Diabetic retinopathy graded by the modified Davis classification · nonmydriatic: 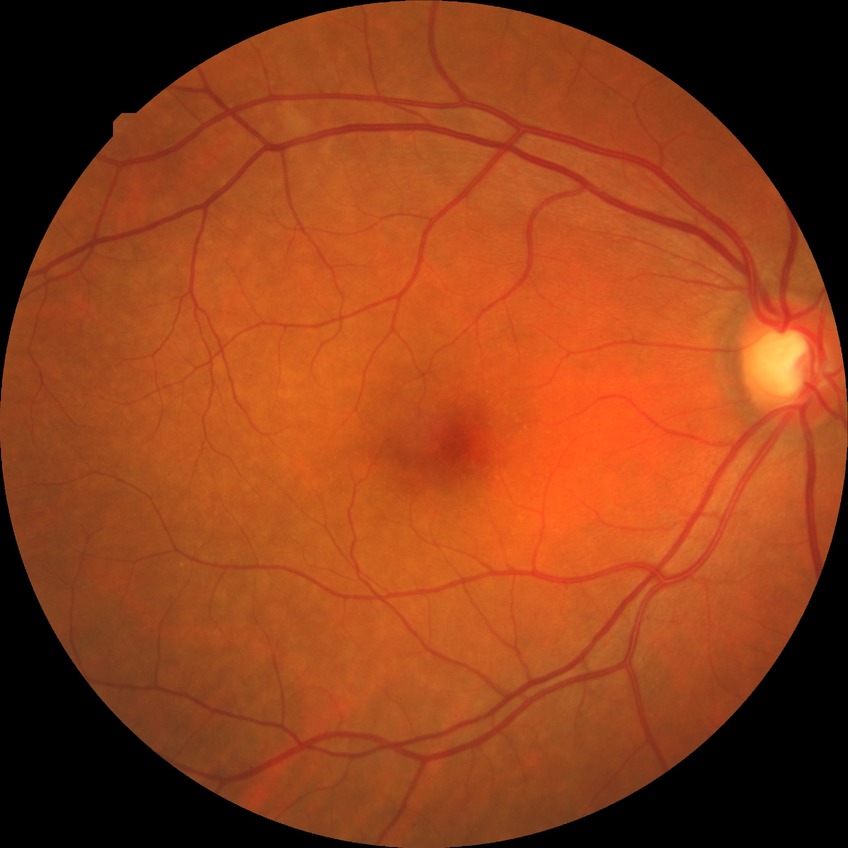

Diabetic retinopathy (DR) is no diabetic retinopathy (NDR).